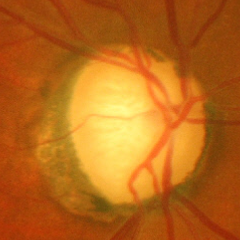
Glaucoma stage: advanced-stage glaucoma.